Color fundus photograph; 1932 by 1932 pixels; FOV: 45 degrees — 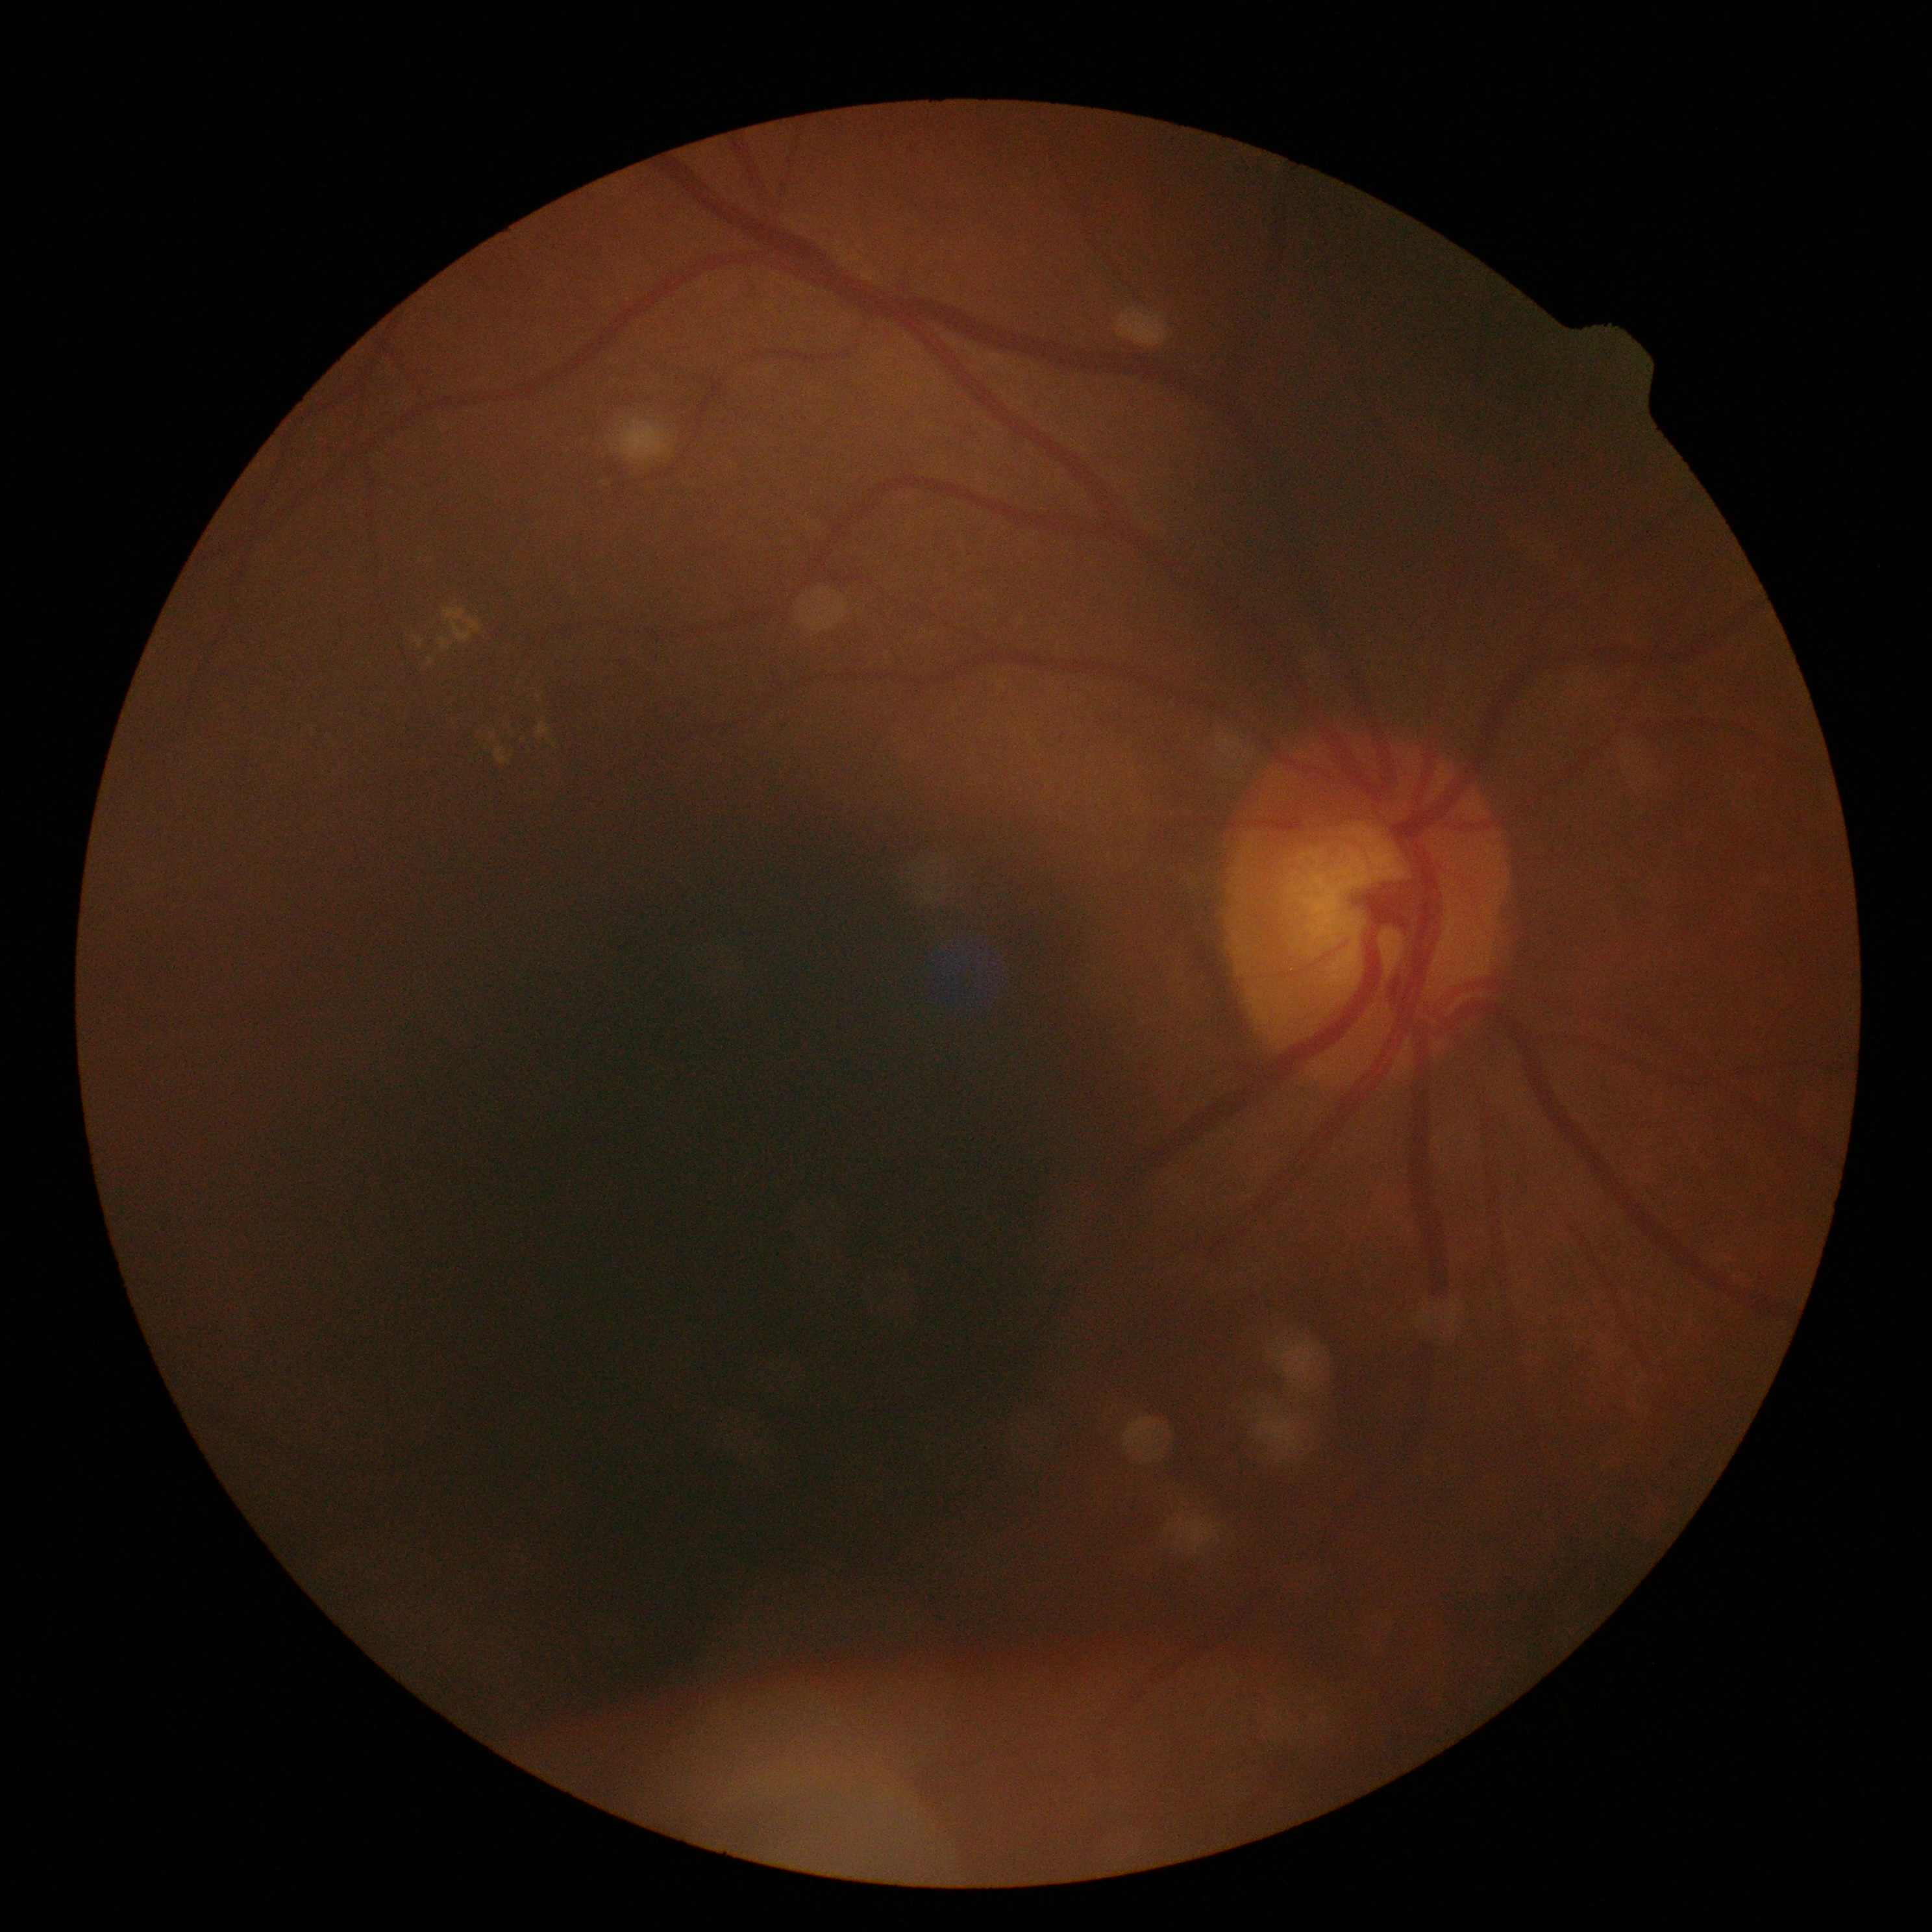
diabetic retinopathy (DR): 2.